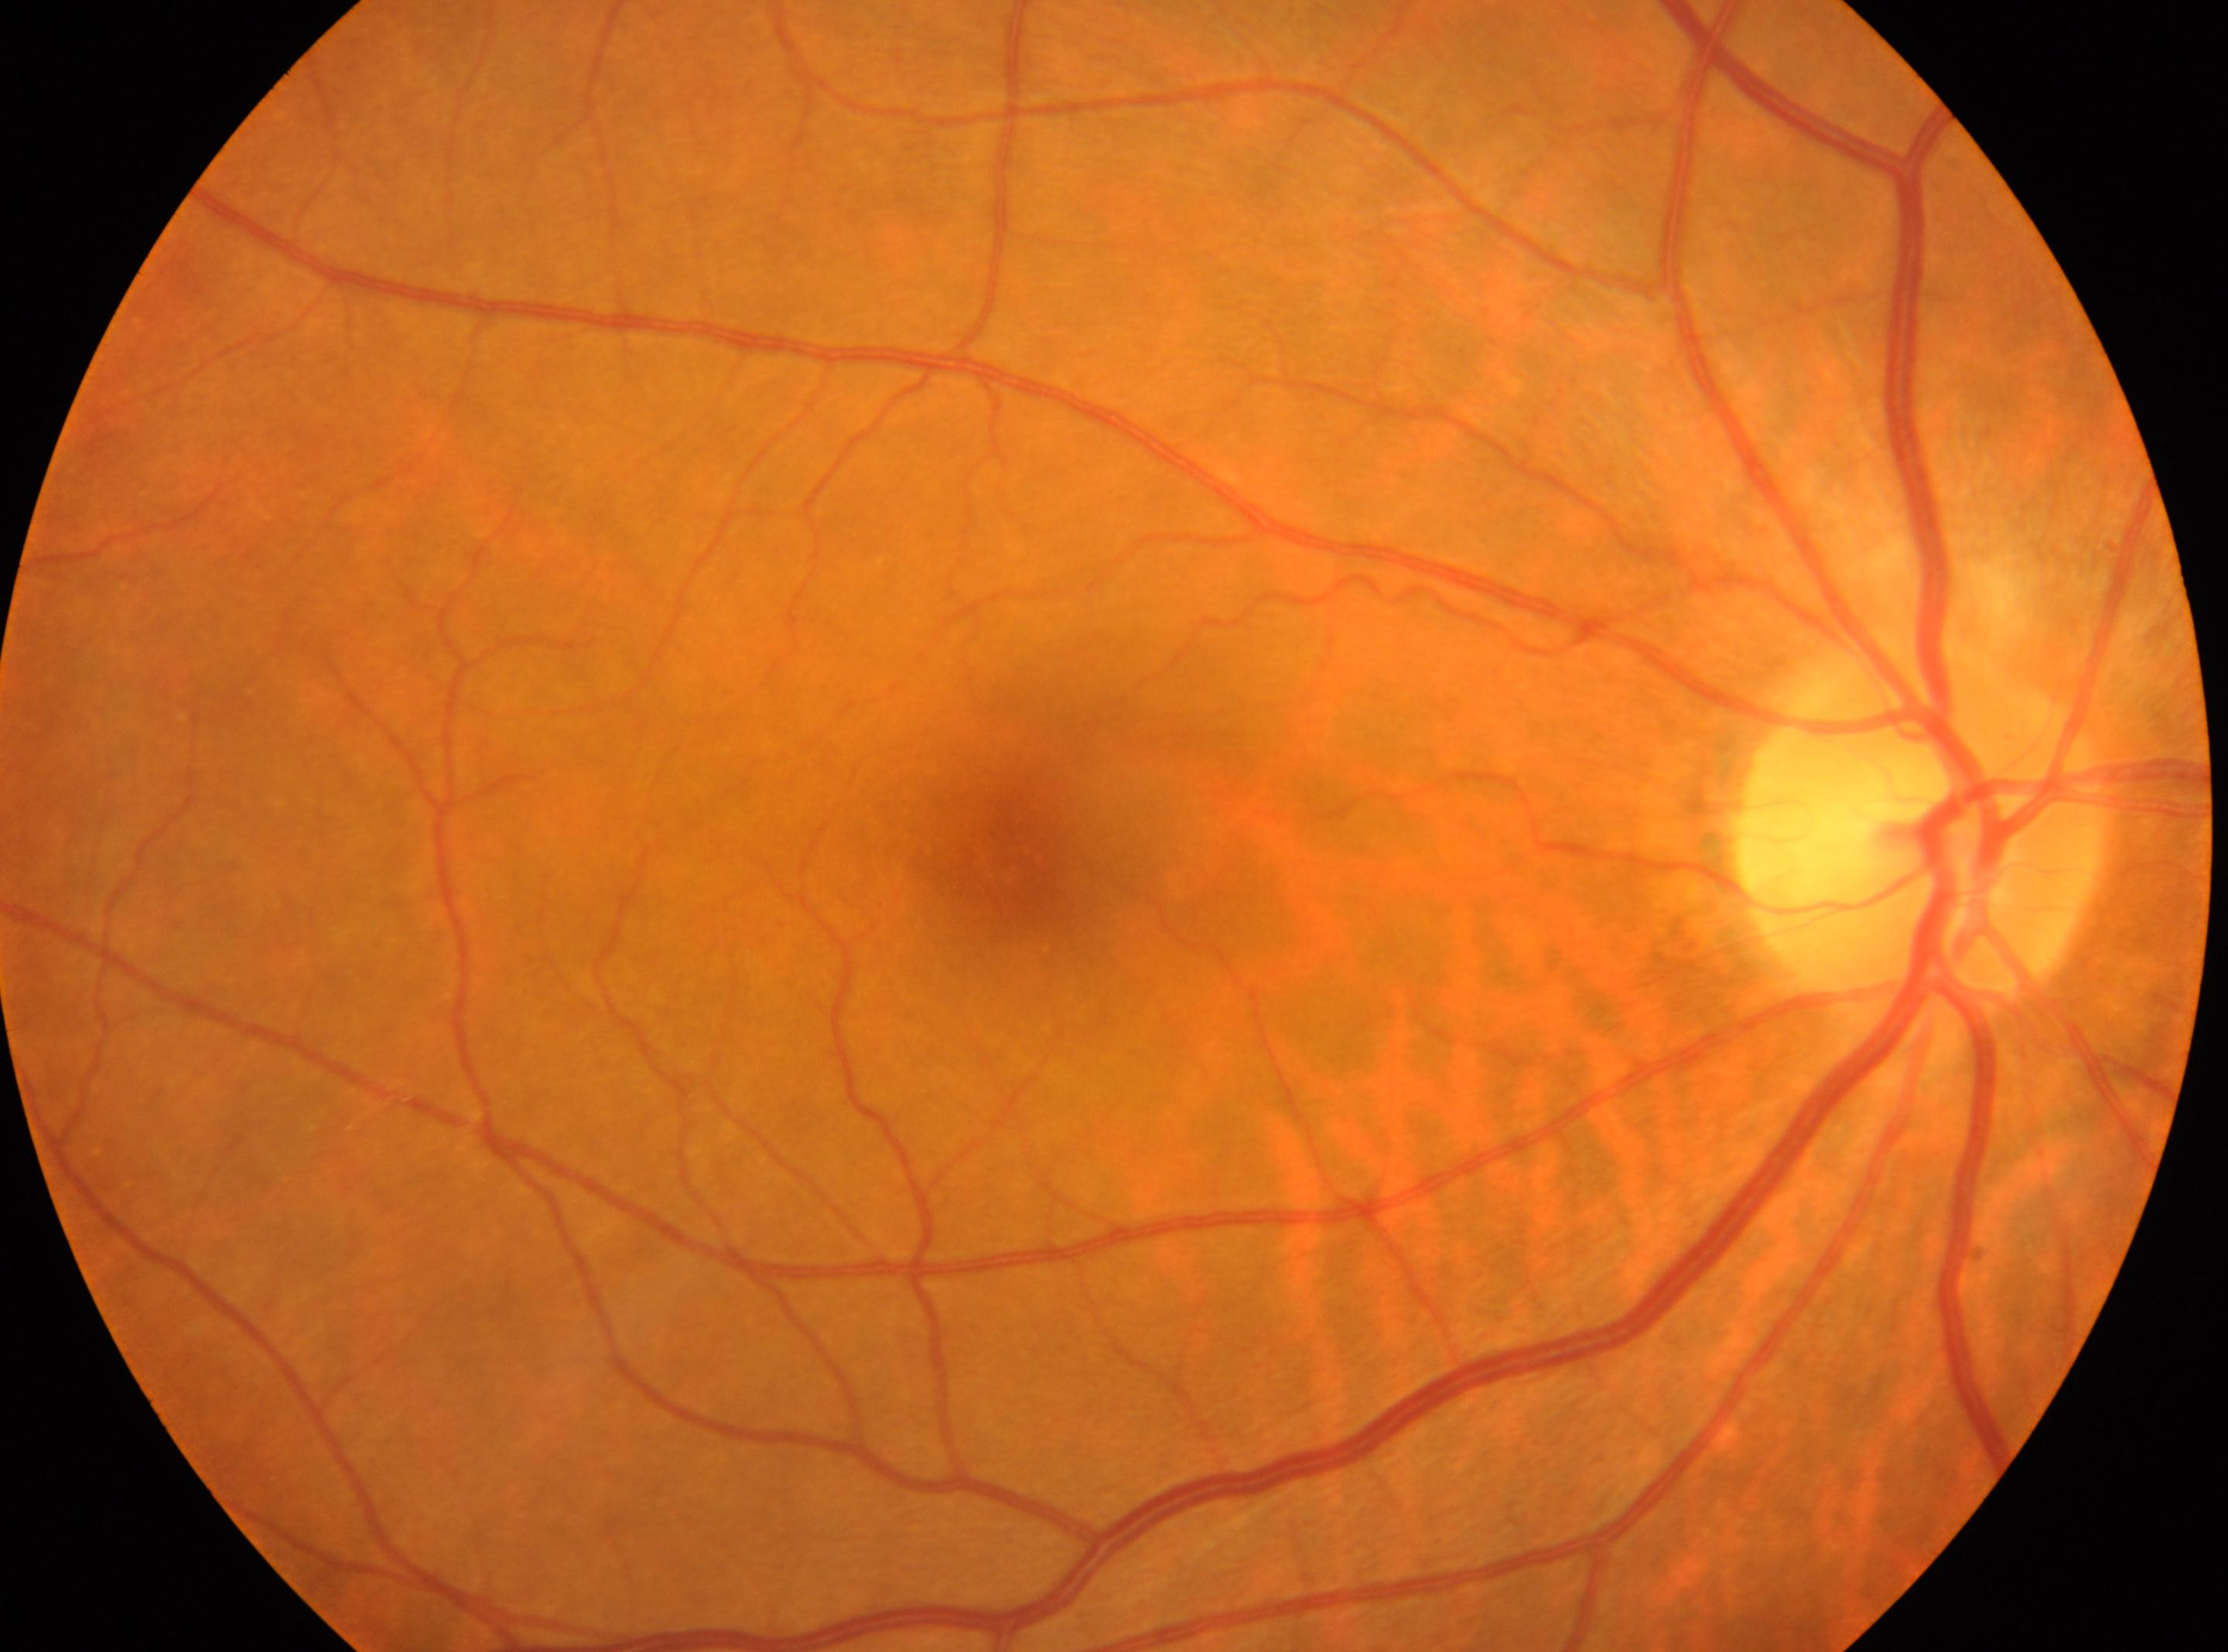
laterality: the right eye | diabetic retinopathy (DR): grade 0 | fovea centralis: (1018, 855) | optic disk: (1919, 833).